Acquired on the Phoenix ICON · wide-field fundus photograph from neonatal ROP screening: 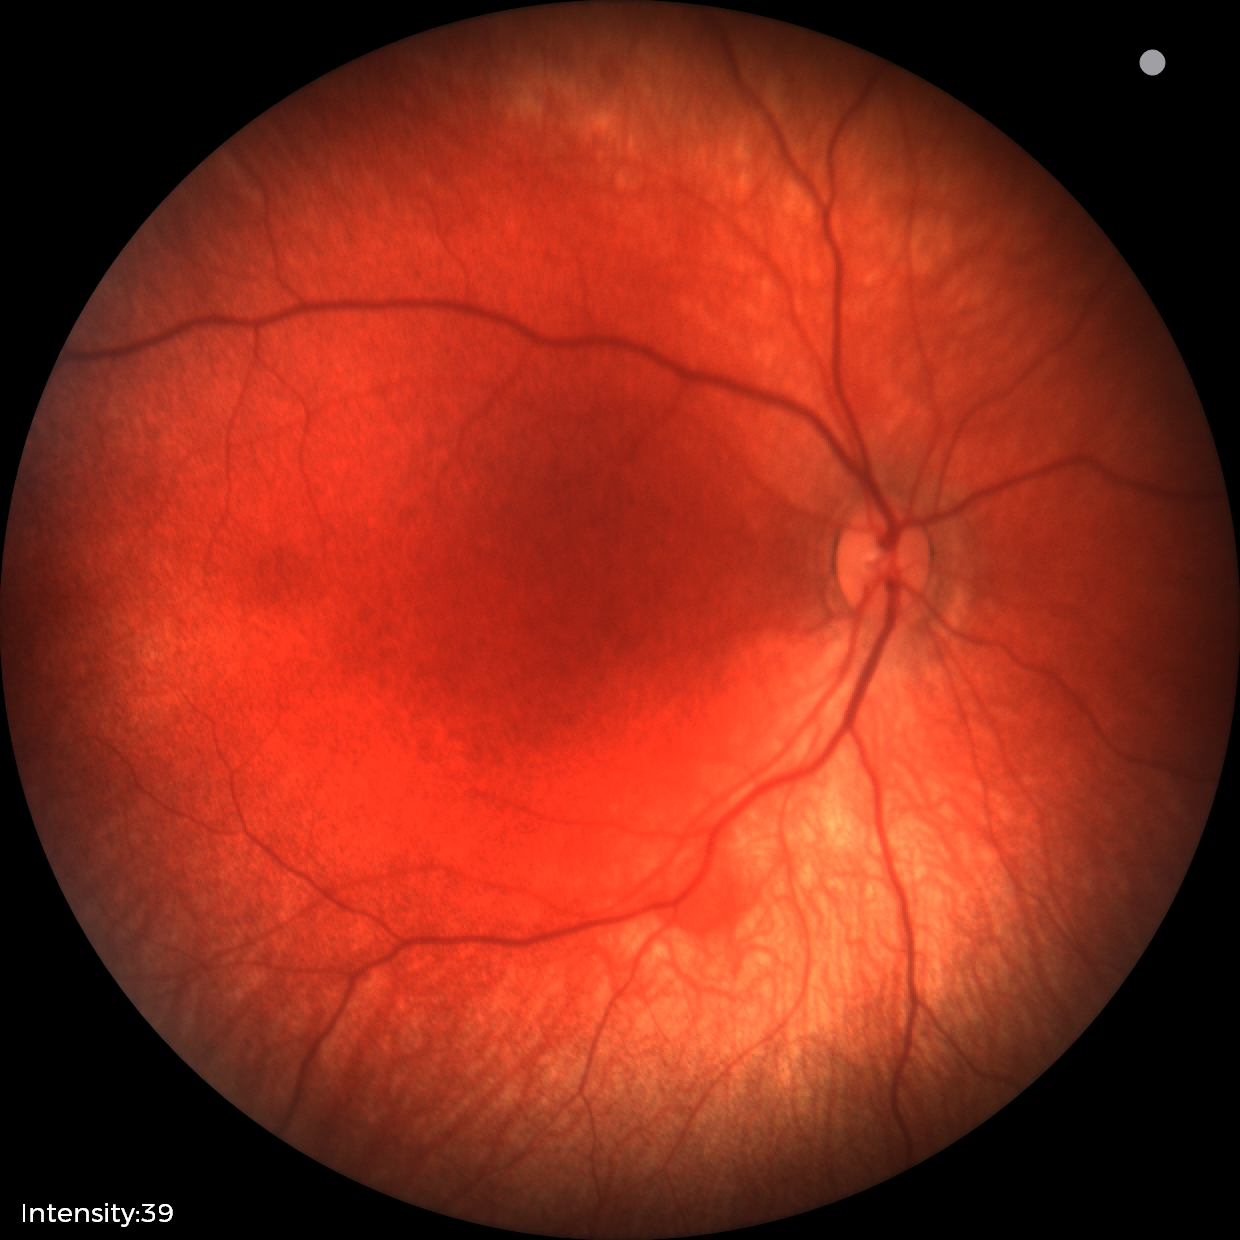

Series diagnosed as retinal hemorrhages.